Refraction: -0.5 -0.75 × 94°. Undilated pupil. Axial length (AL): 24.3 mm. Captured on a Topcon TRC-NW400 fundus camera.
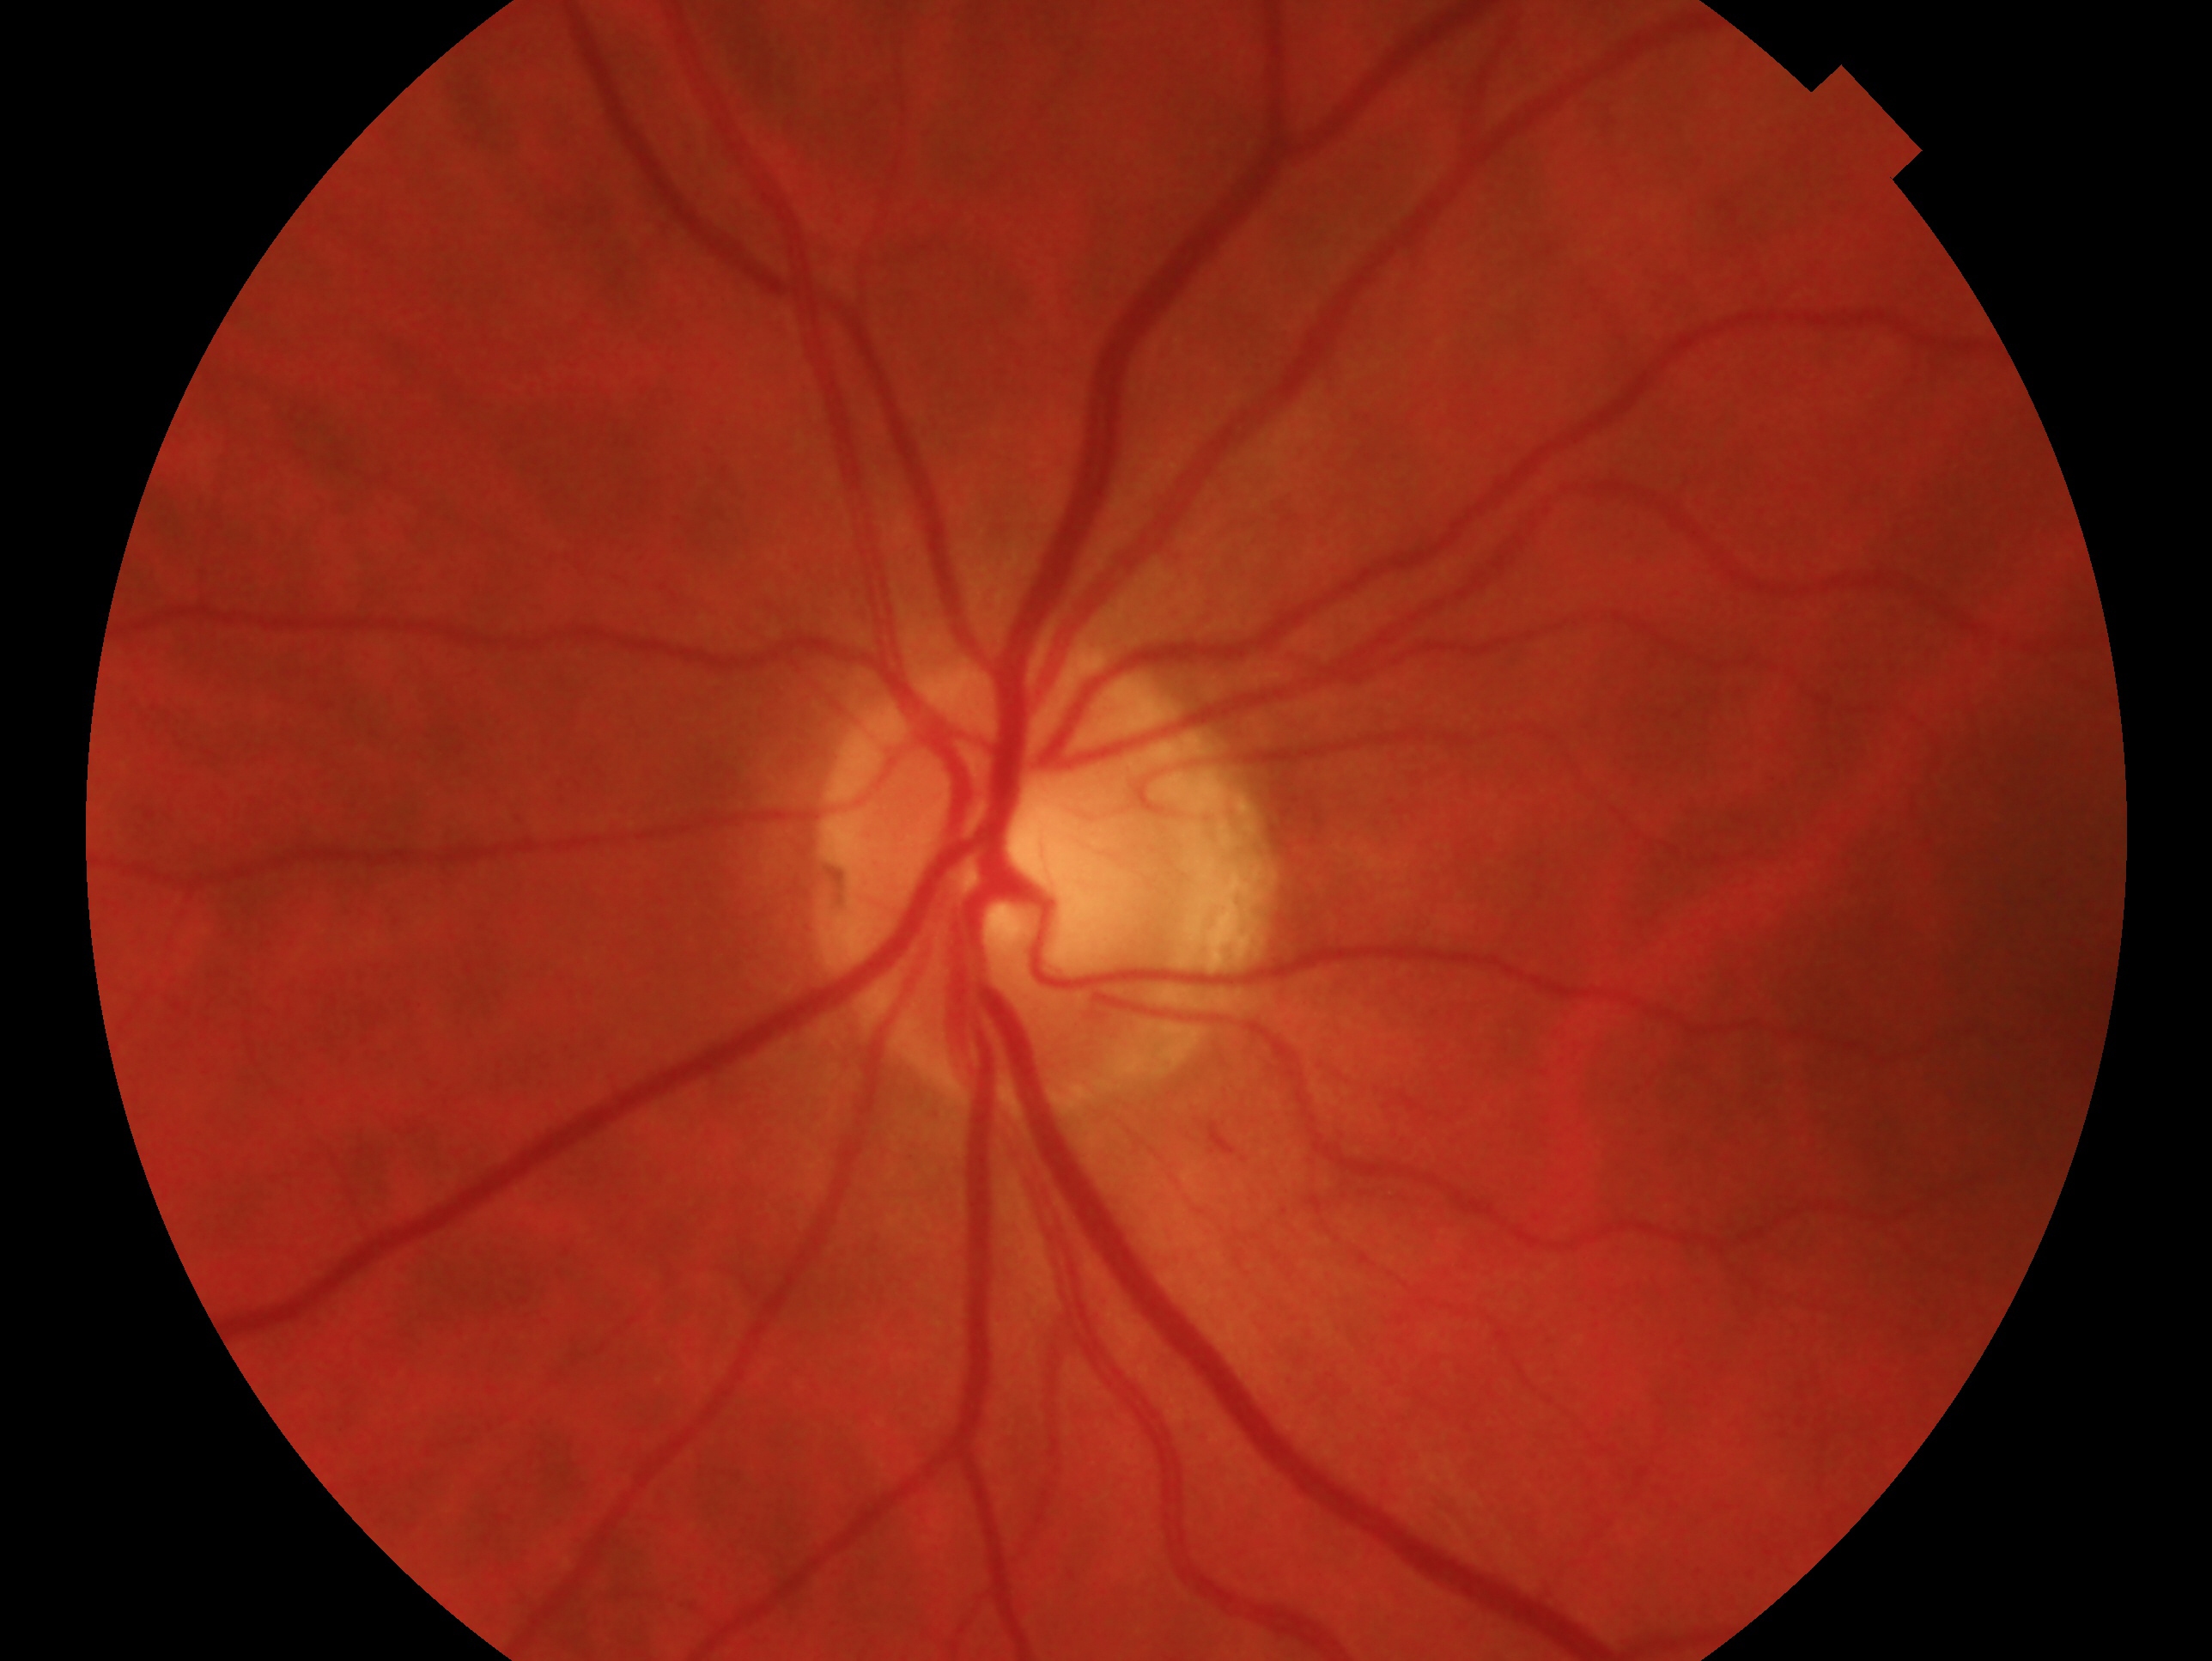
Q: What is the laterality?
A: OS
Q: What is the glaucoma status of this eye?
A: no signs of glaucoma